Camera: Nidek AFC-330
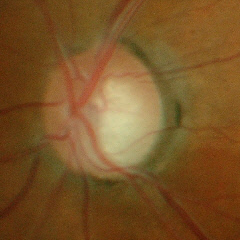

Early-stage glaucoma.